640x480px · infant wide-field retinal image: 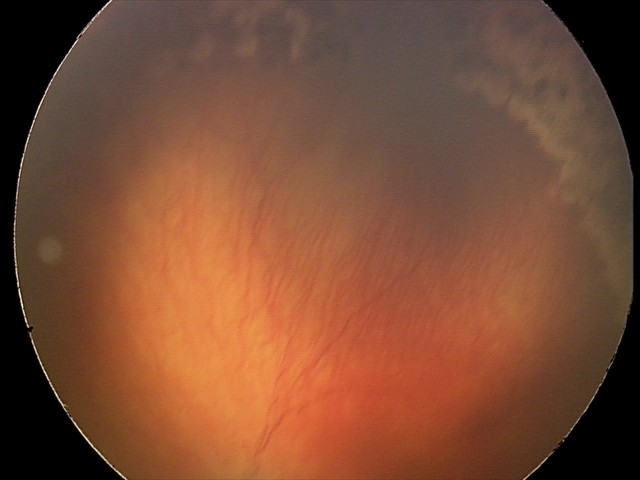

Q: Is plus disease present?
A: plus disease
Q: What was the screening finding?
A: A-ROP (aggressive ROP)